Wide-field fundus photograph of an infant.
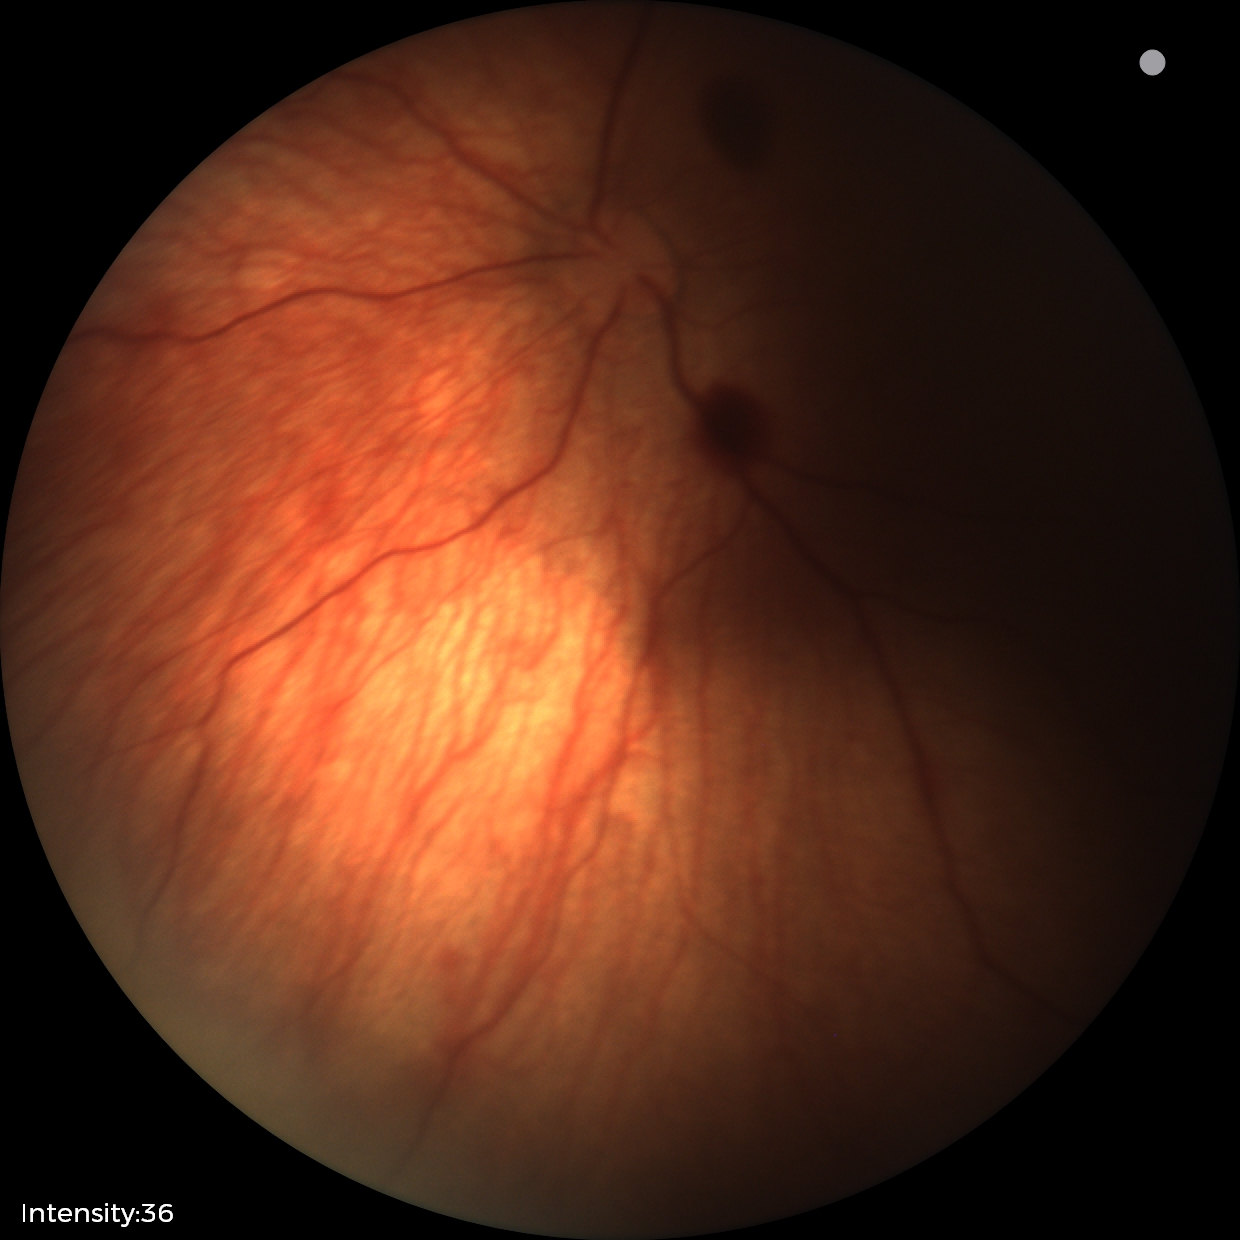 Examination diagnosed as retinal hemorrhages.